Fundus photo. Image size 240x240.
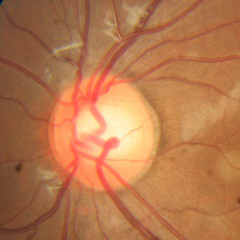

There is evidence of no signs of glaucoma.